Fundus photo; image size 1920x1440:
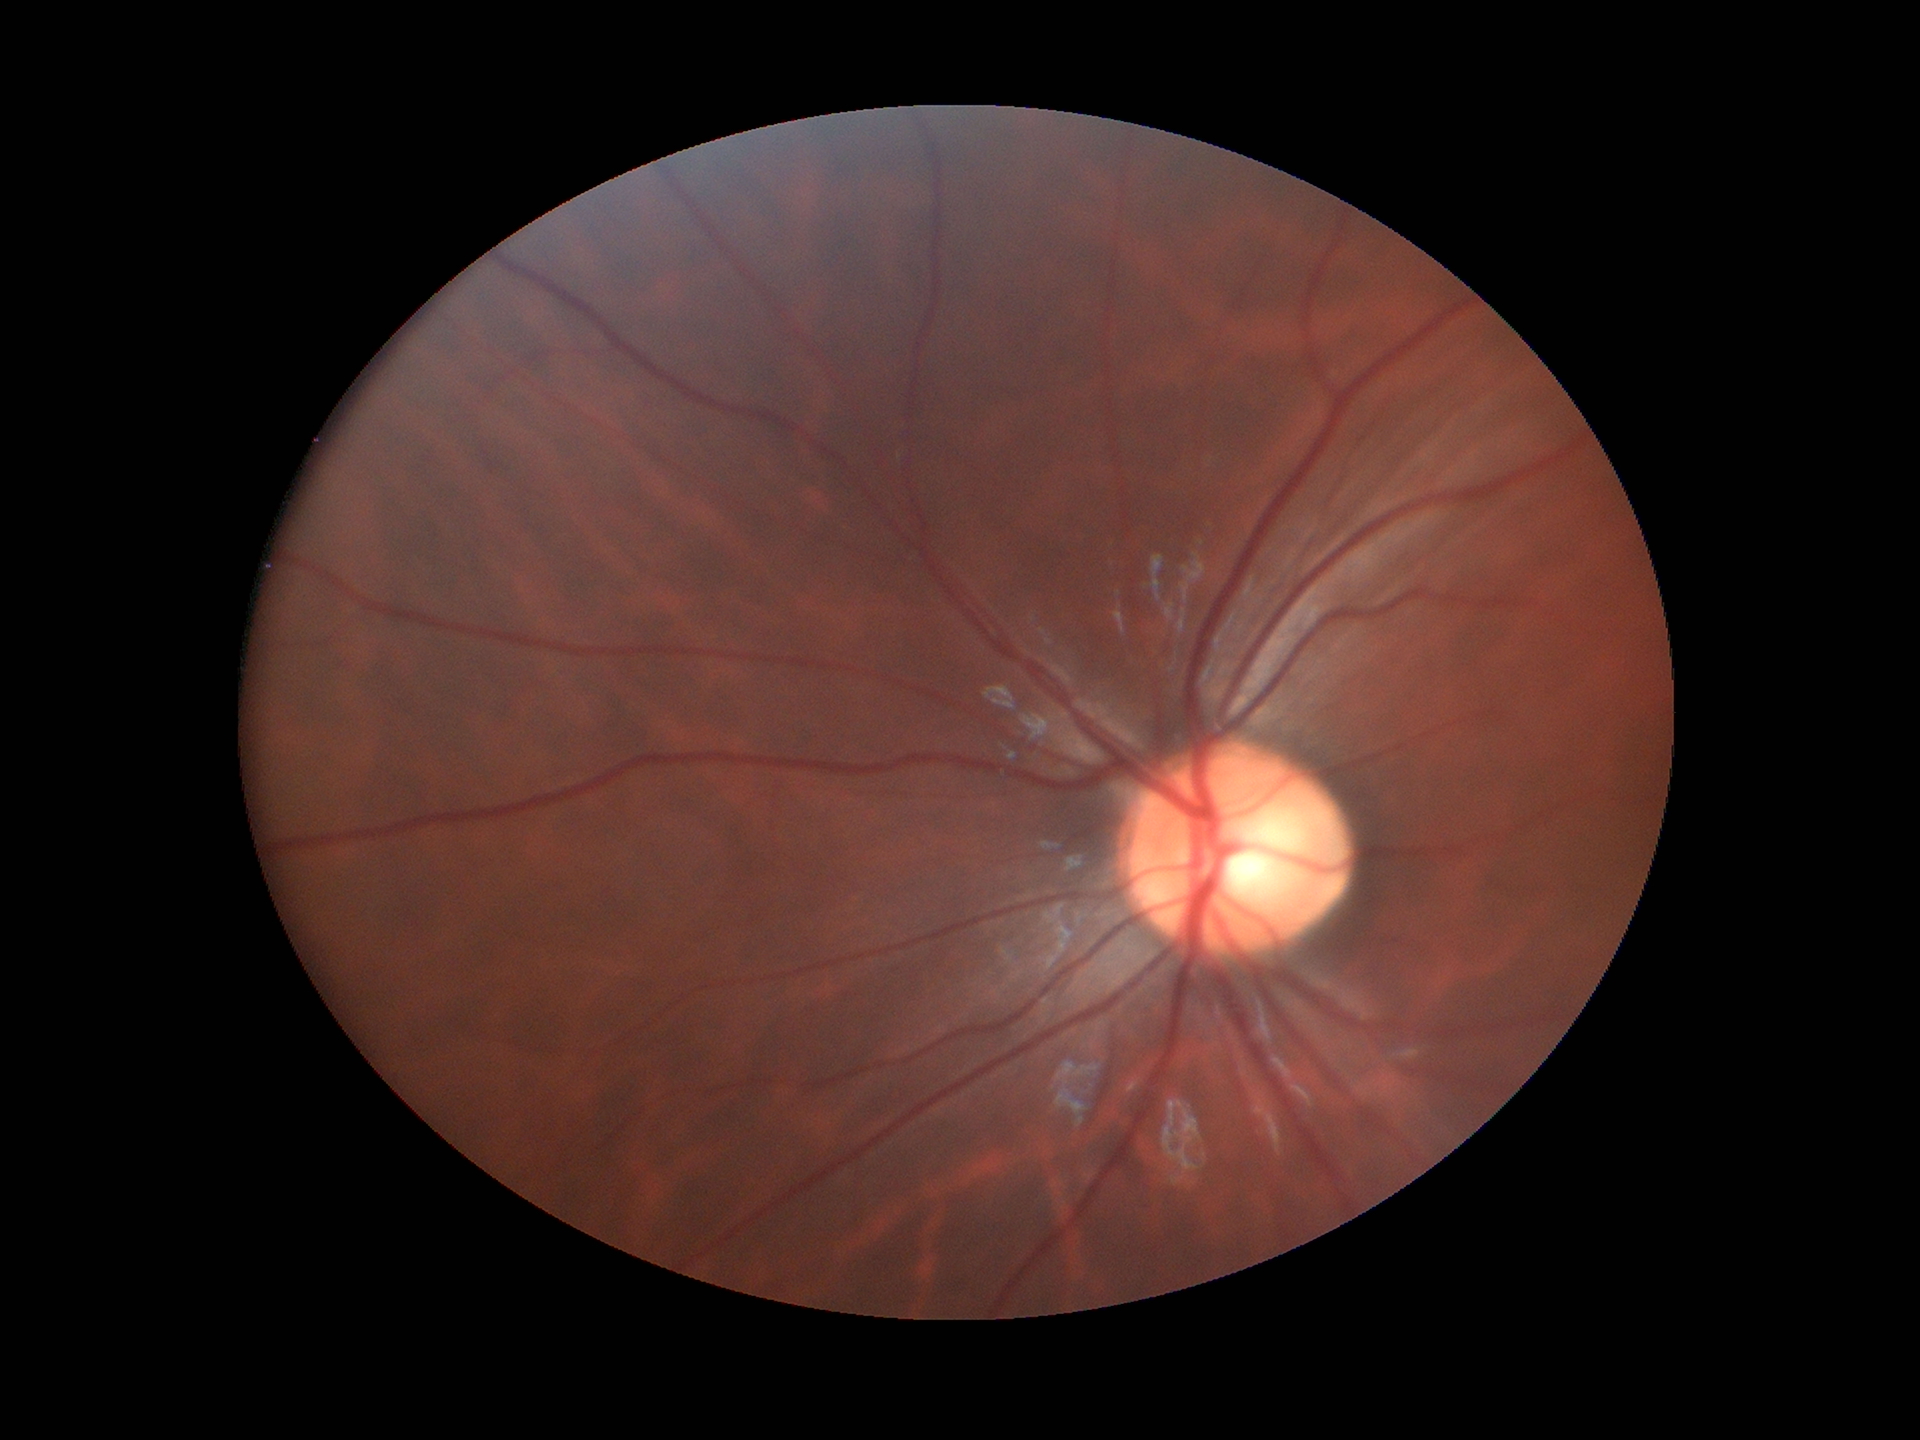
  hcdr: 0.59
  acdr: 0.32
  vcdr: 0.54
  glaucoma_decision: not suspect